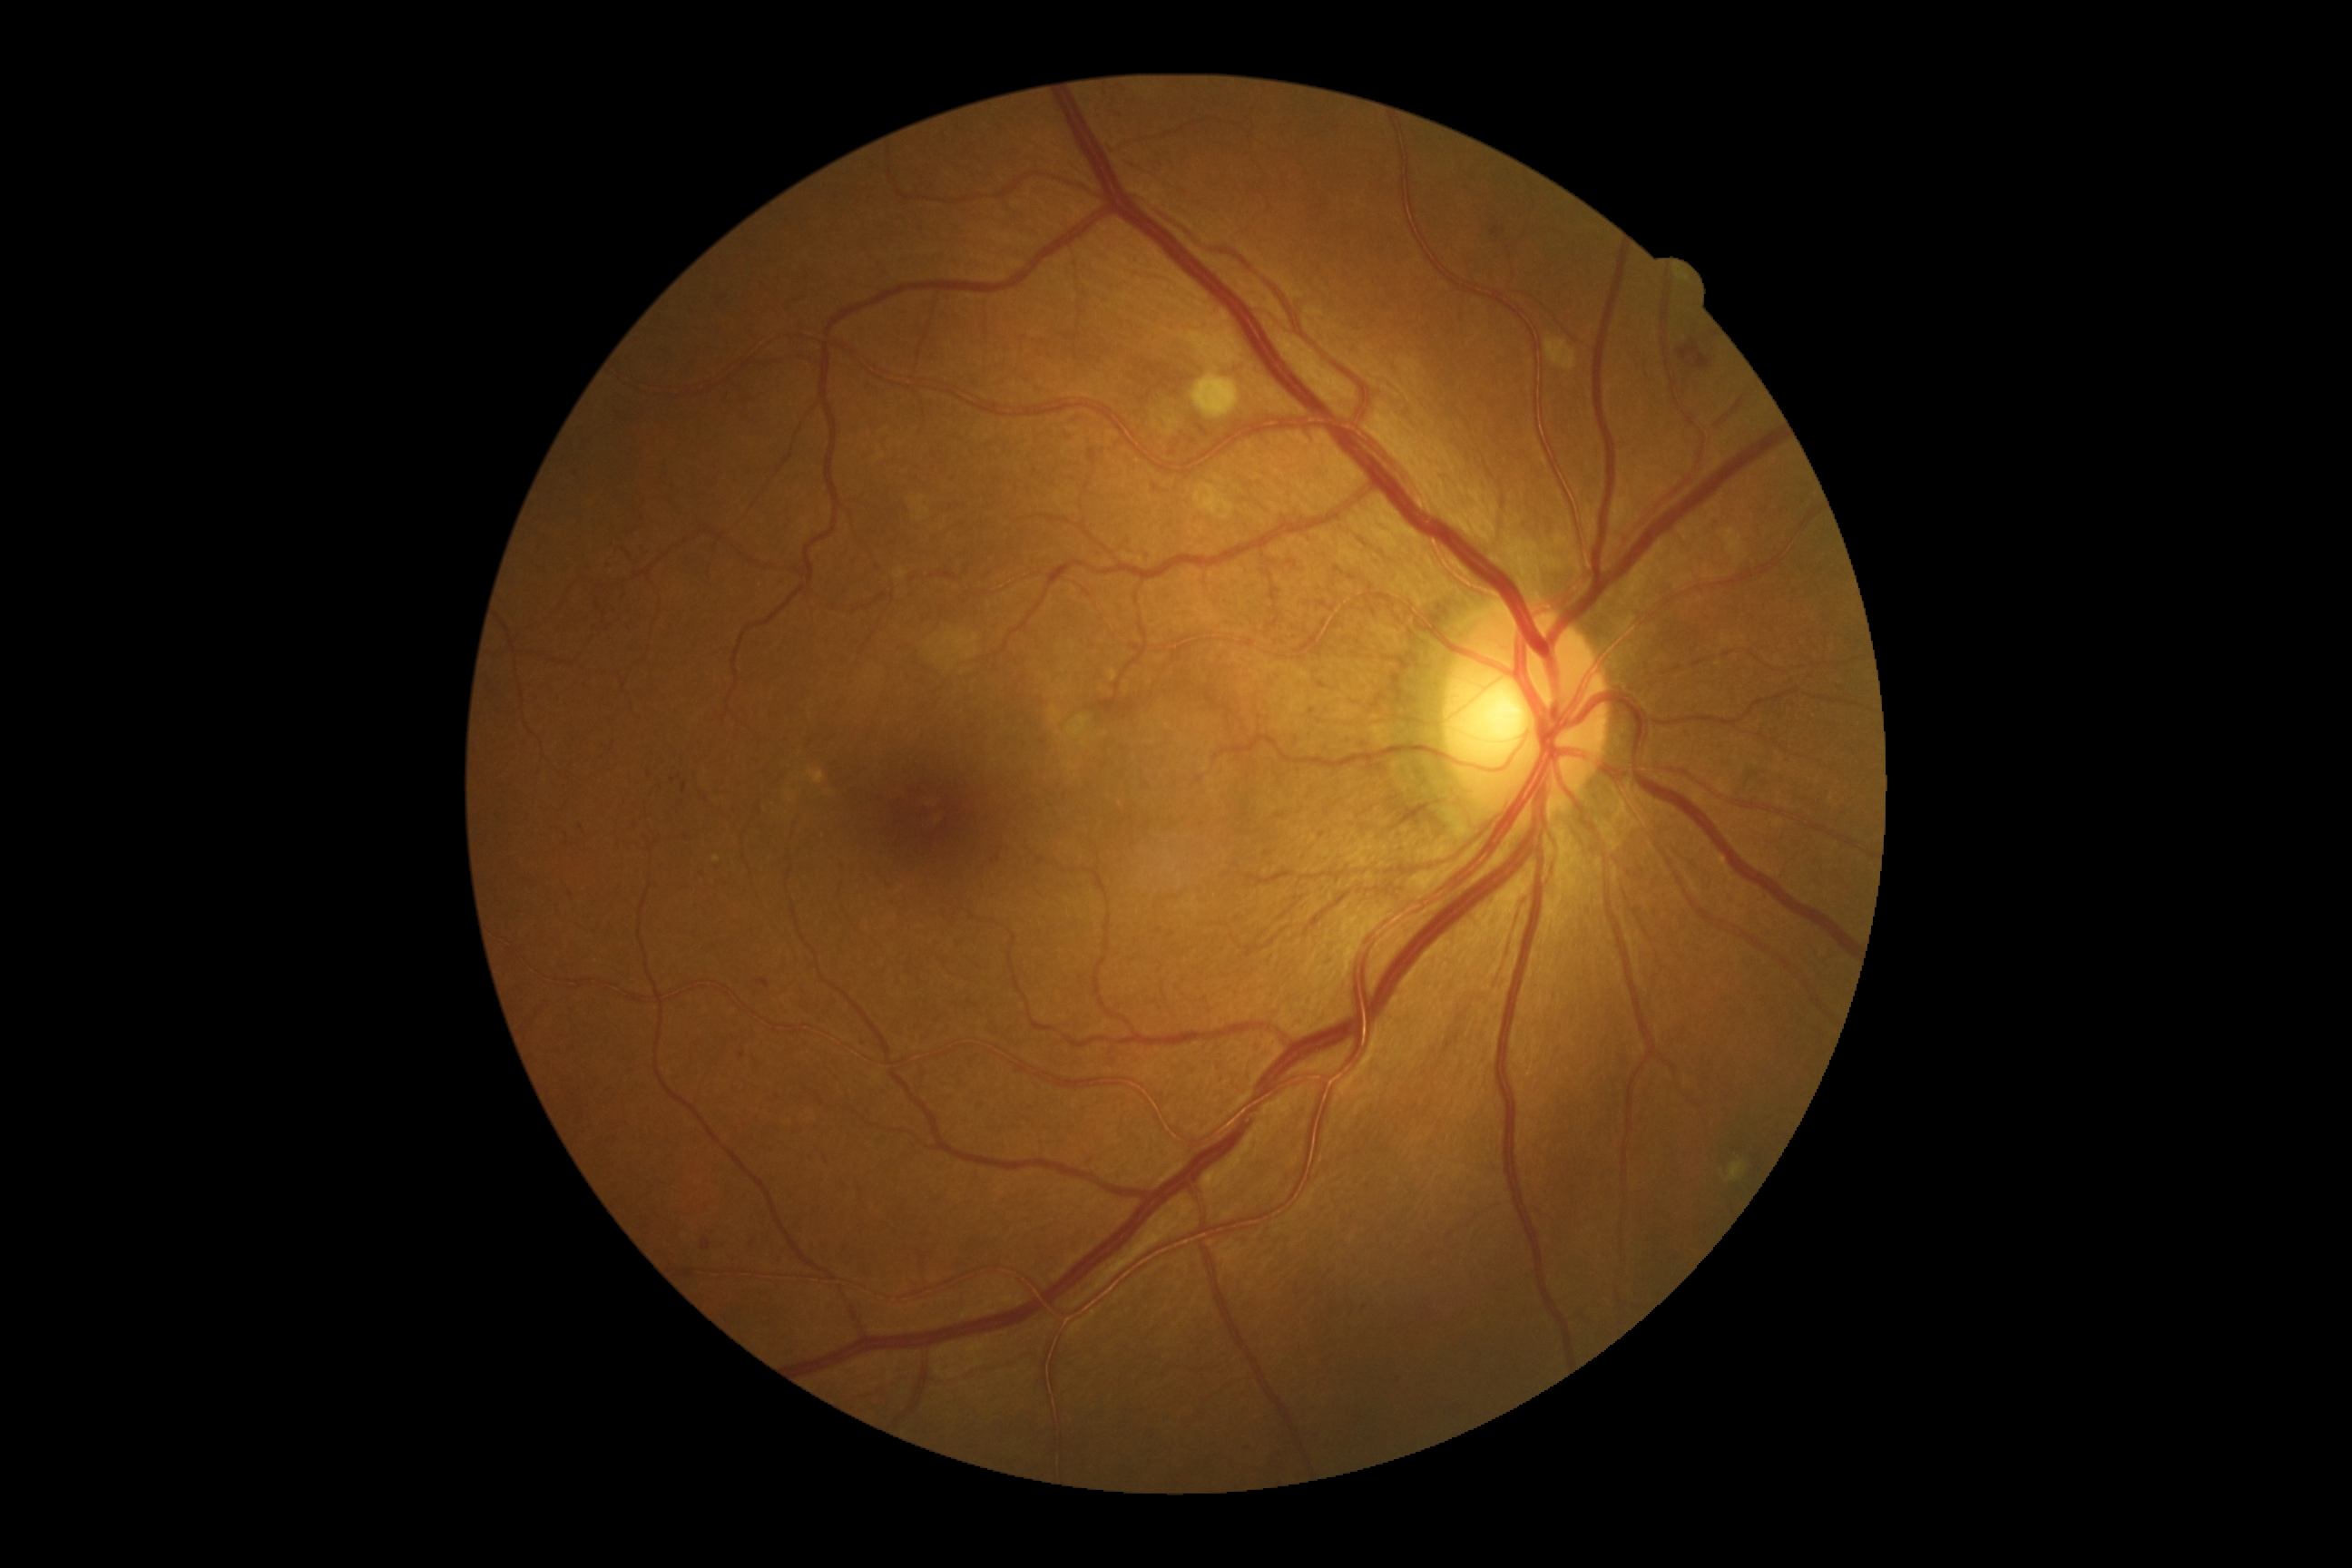 Diabetic retinopathy severity: severe NPDR (grade 3).